Nonmydriatic fundus photograph, CFP, 848x848
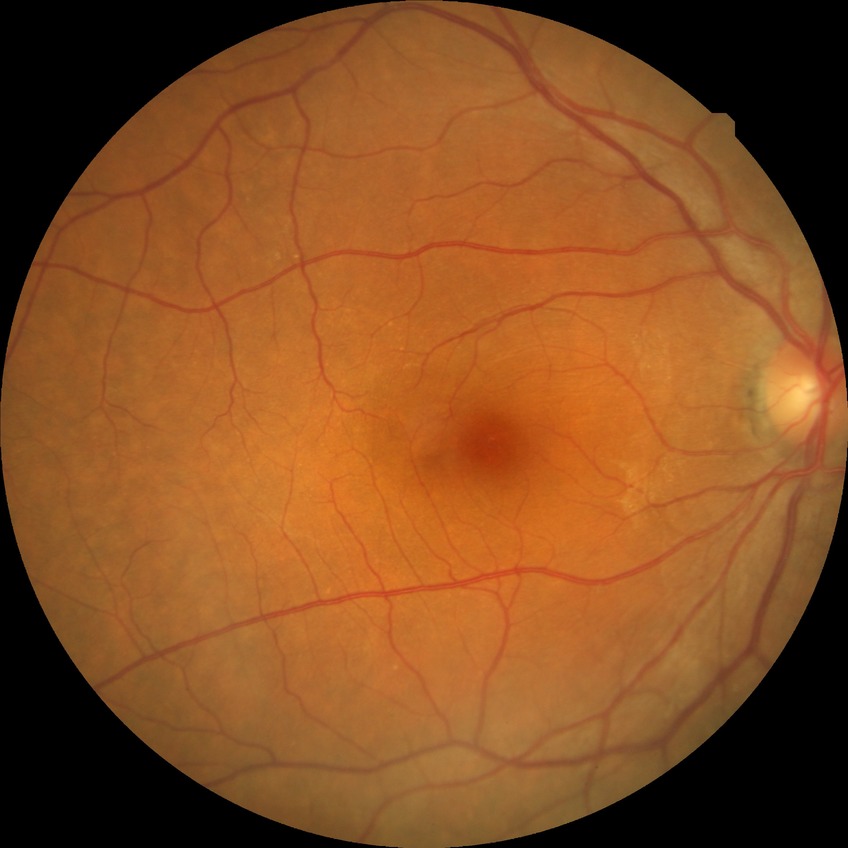

Retinopathy stage is no diabetic retinopathy.